45-degree field of view. 2212 x 1659 pixels. Fundus photo.
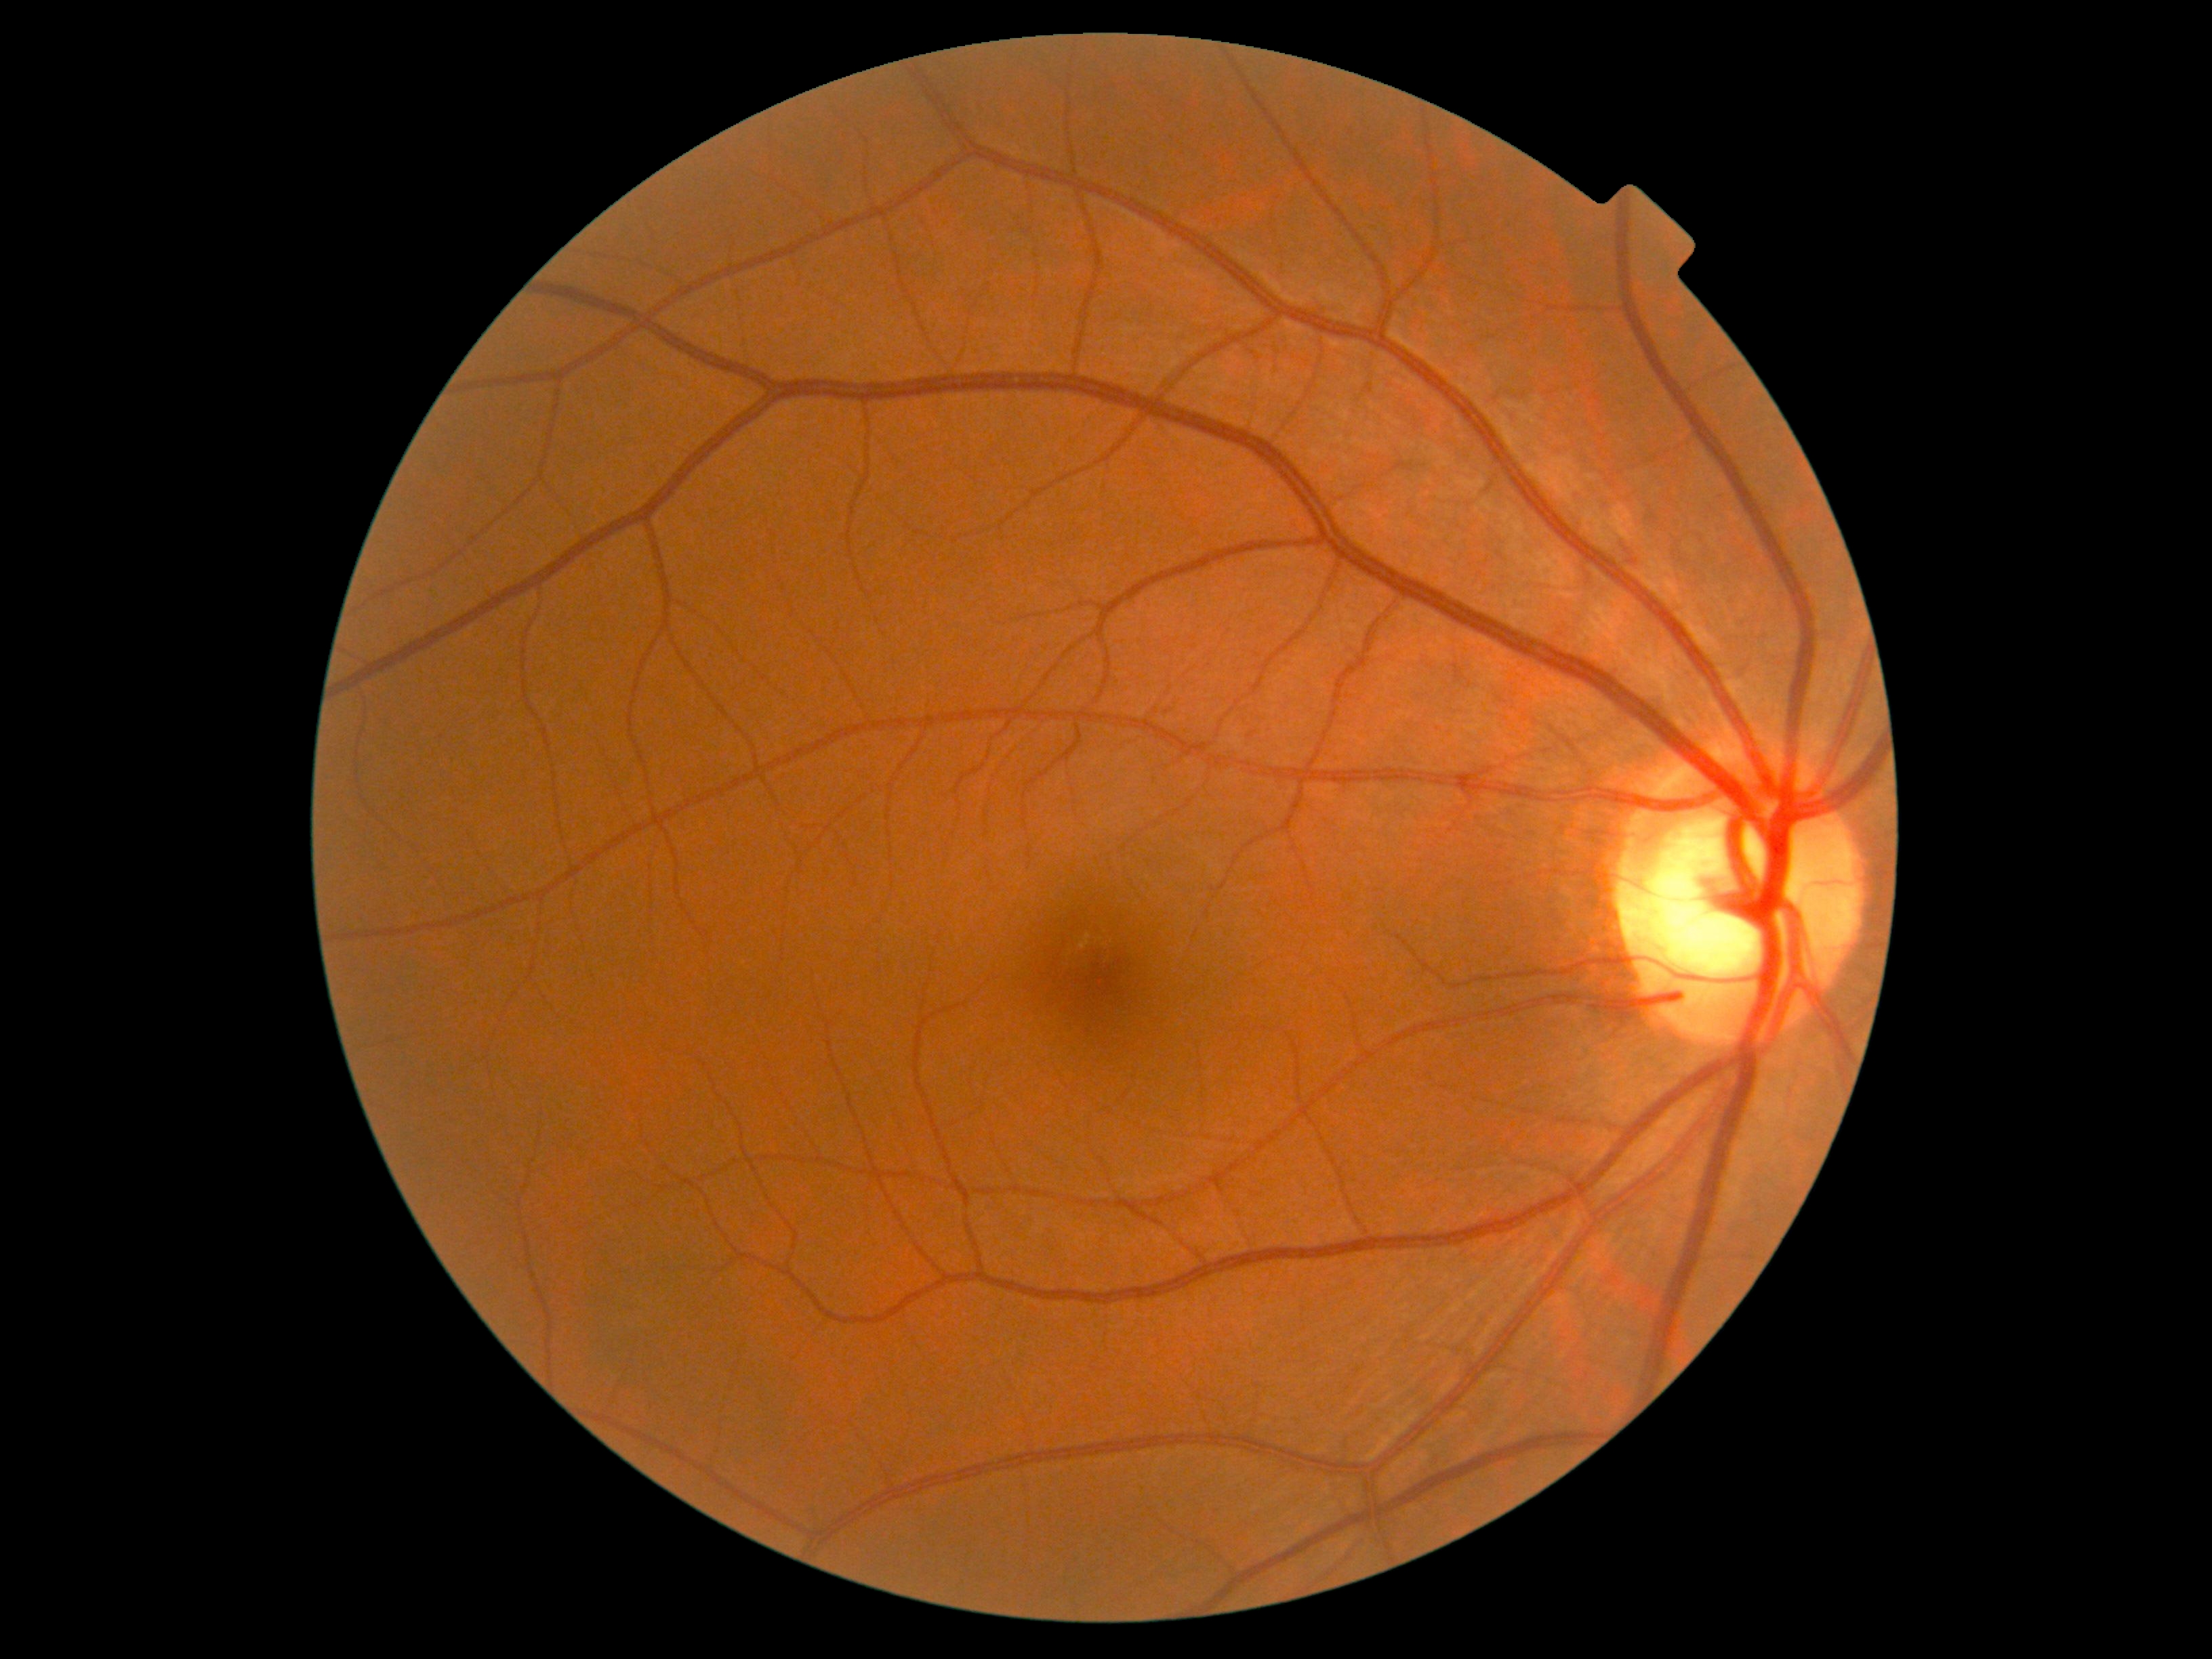 DR: grade 0 (no apparent retinopathy). No apparent diabetic retinopathy.